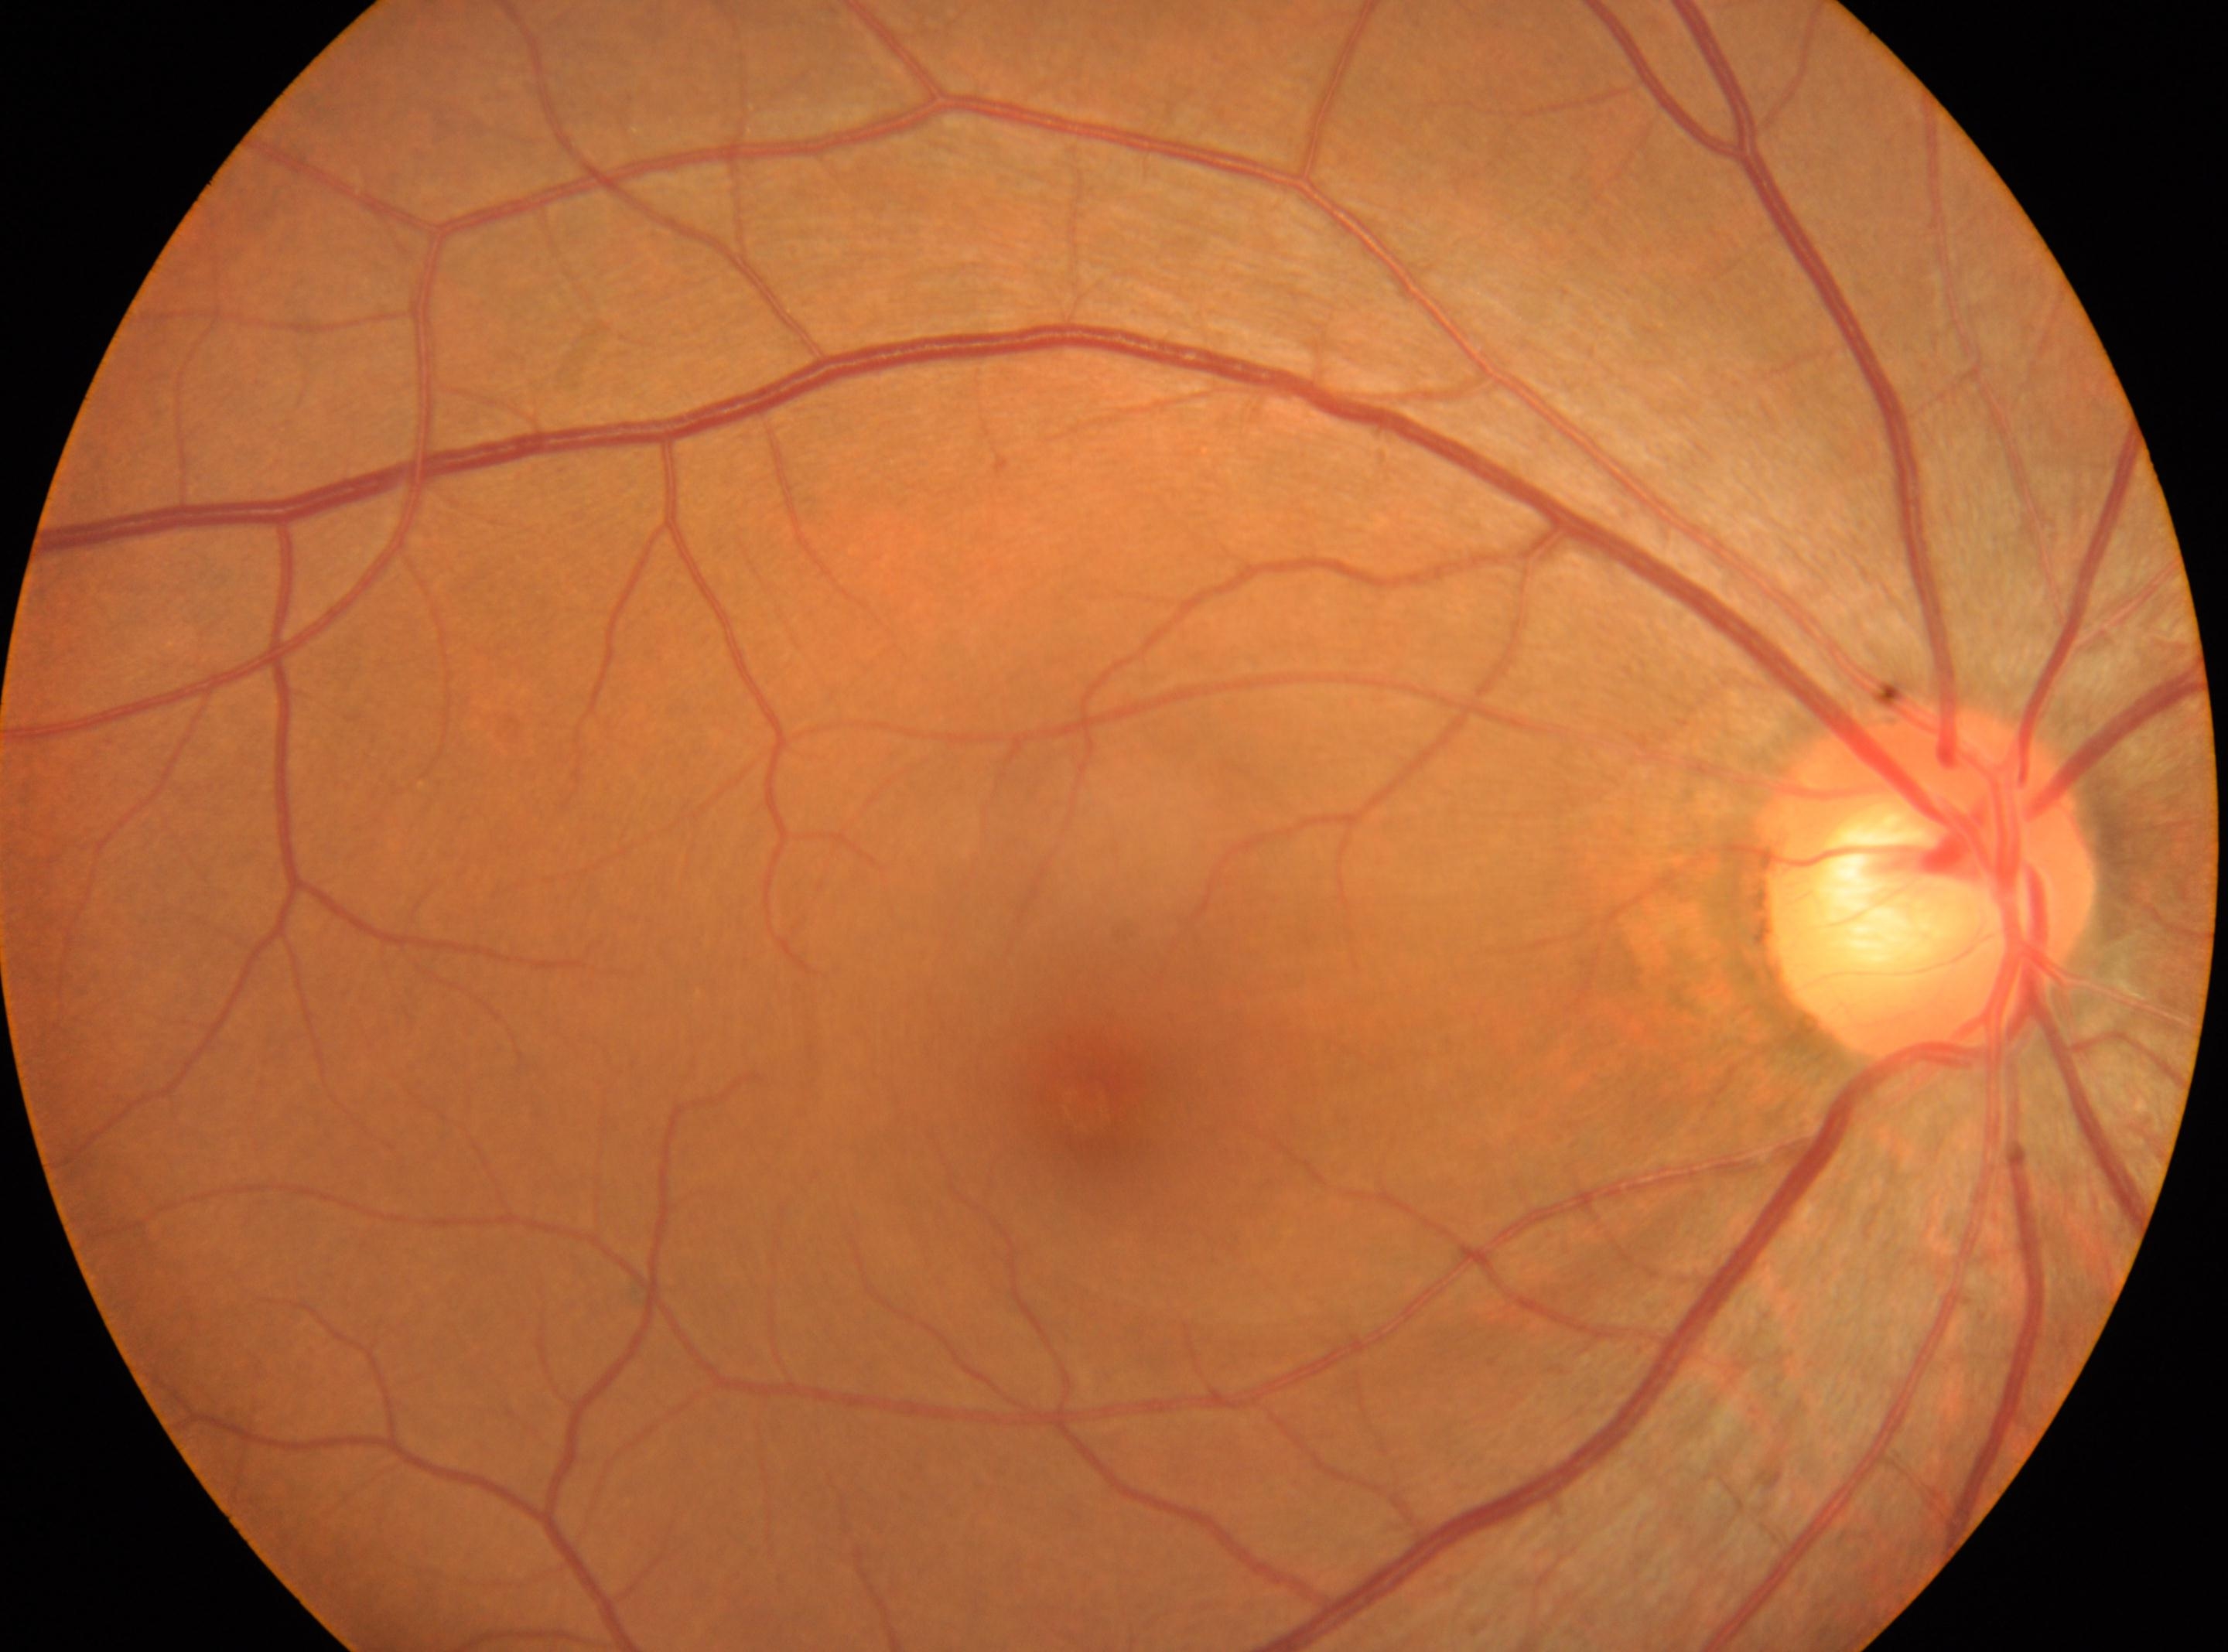 Annotations:
- macular center — (x: 1086, y: 1106)
- laterality — oculus dexter
- diabetic retinopathy (DR) — grade 0 — no visible signs of diabetic retinopathy
- DR impression — No signs of diabetic retinopathy
- disc center — (x: 1928, y: 882)